Pupil-dilated:
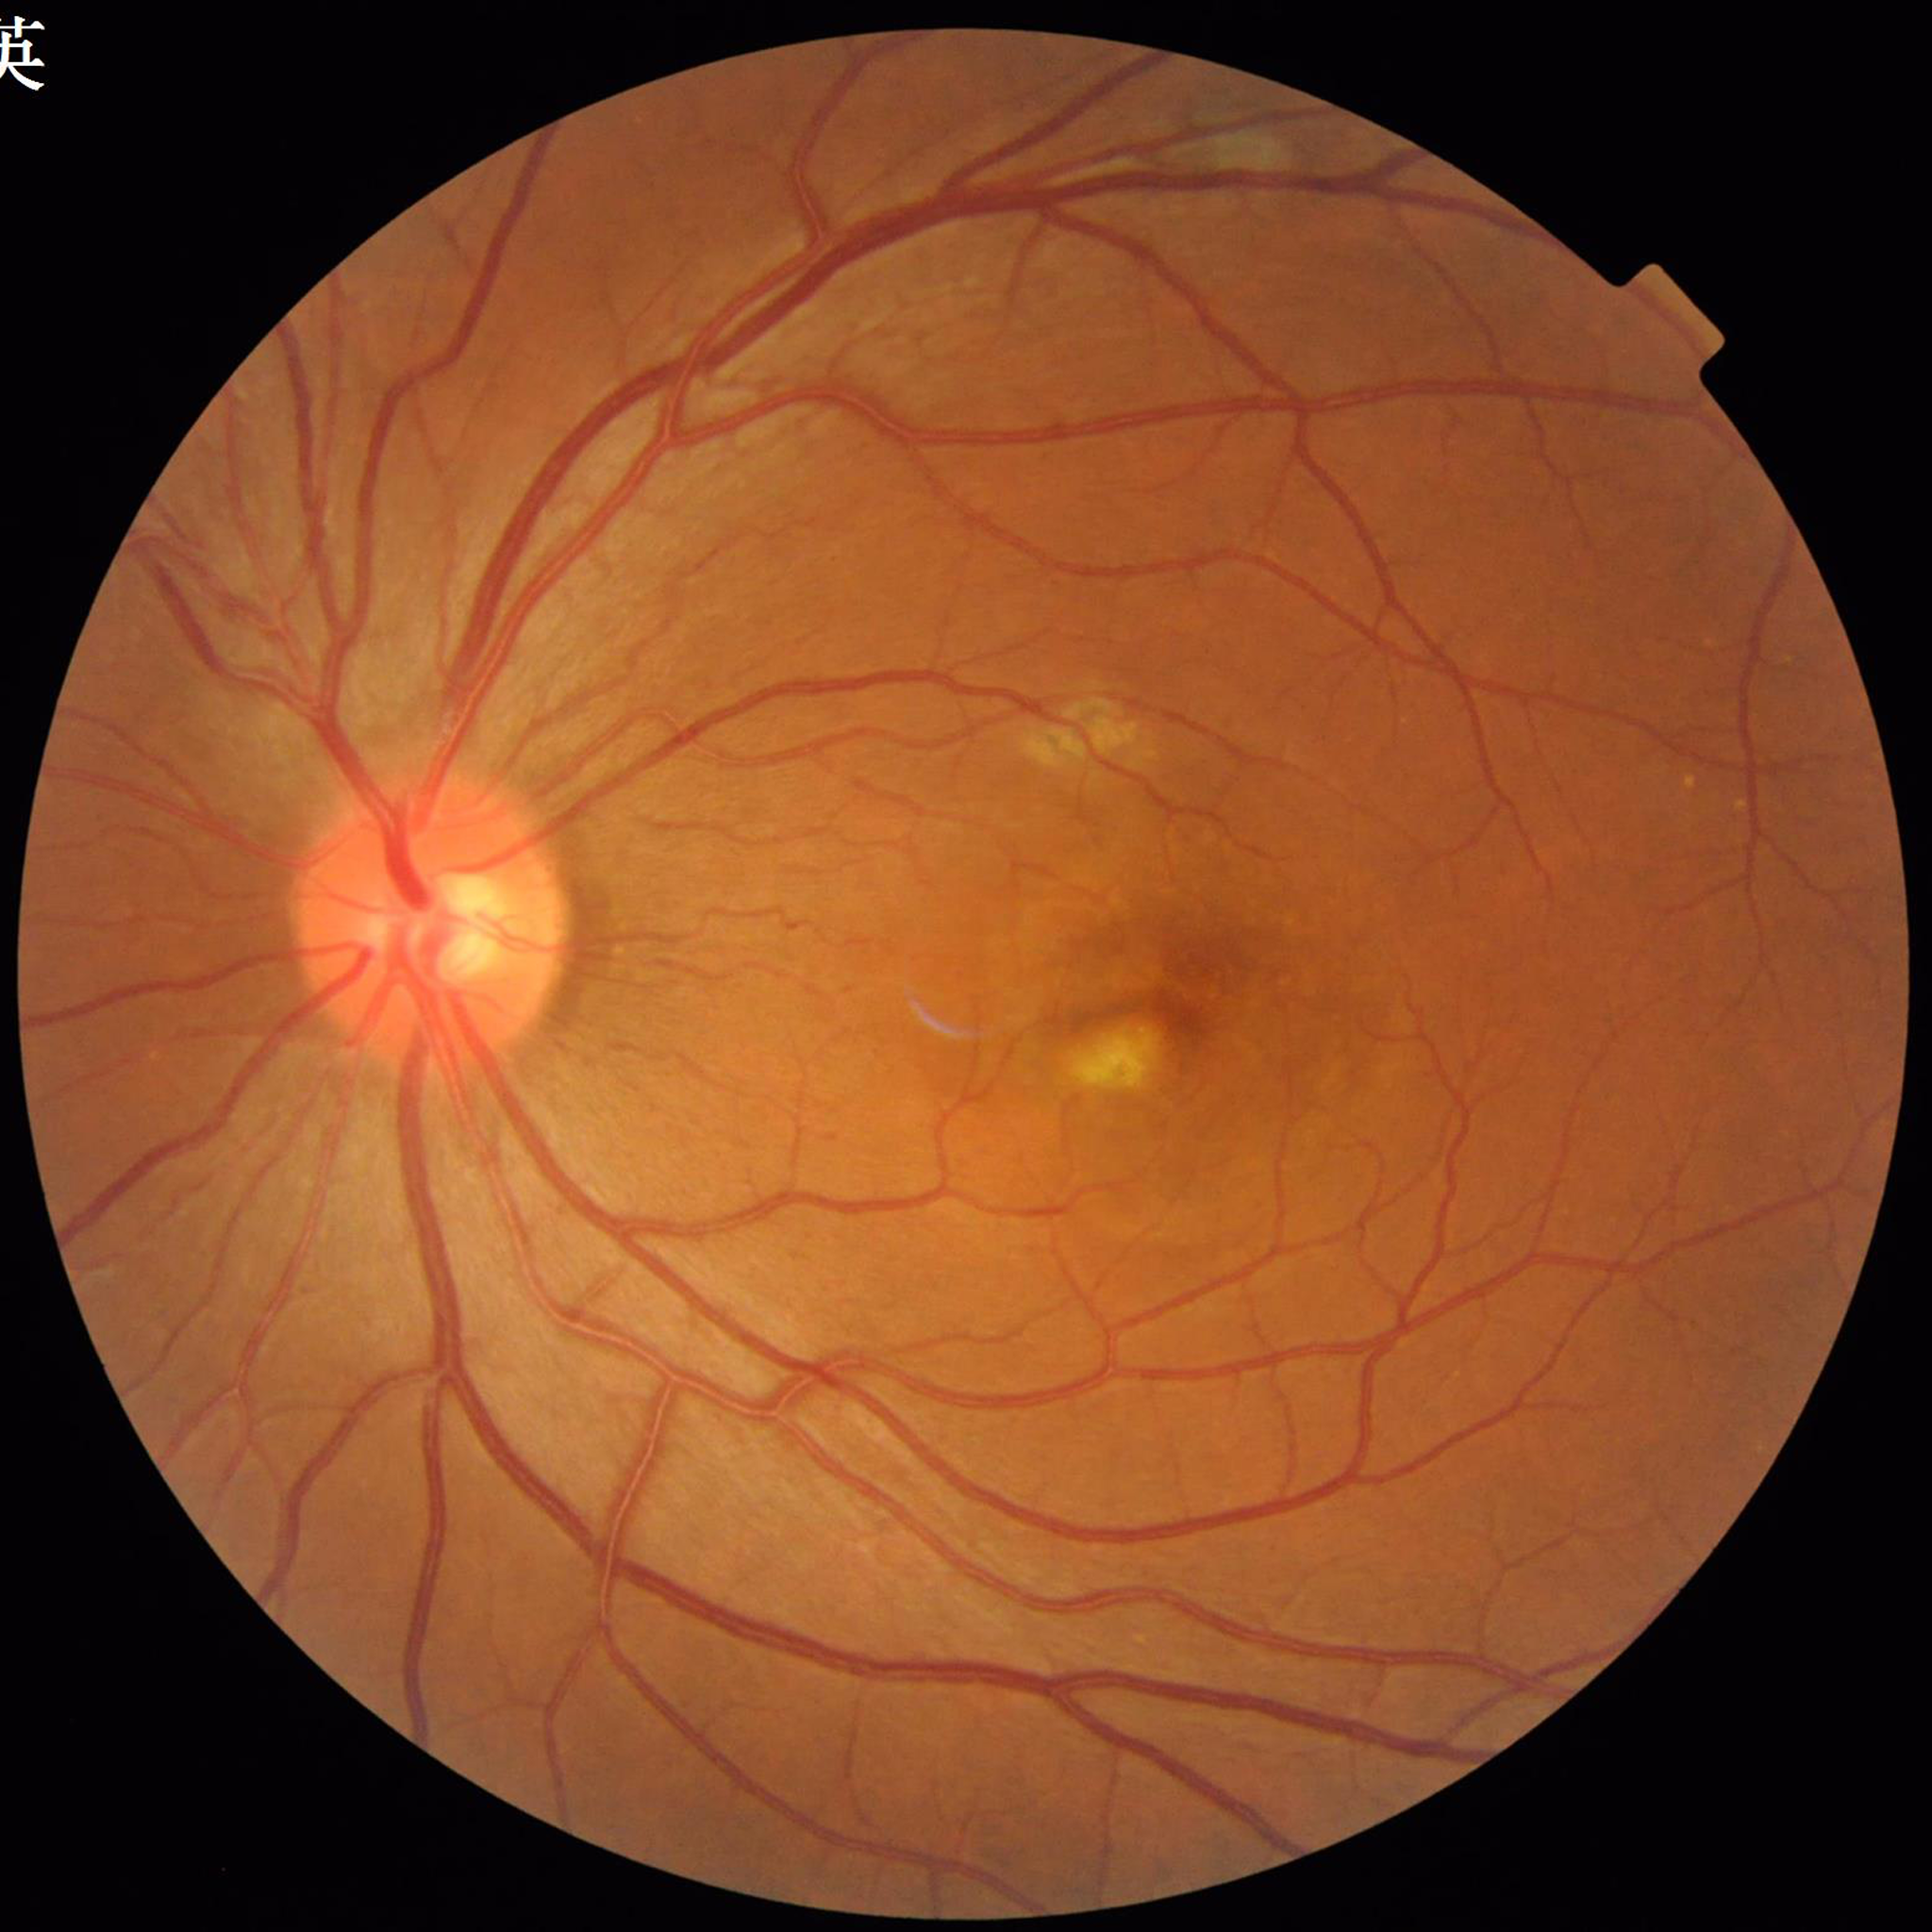

Image quality: no concerns identified
Disease: age-related macular degeneration (AMD)